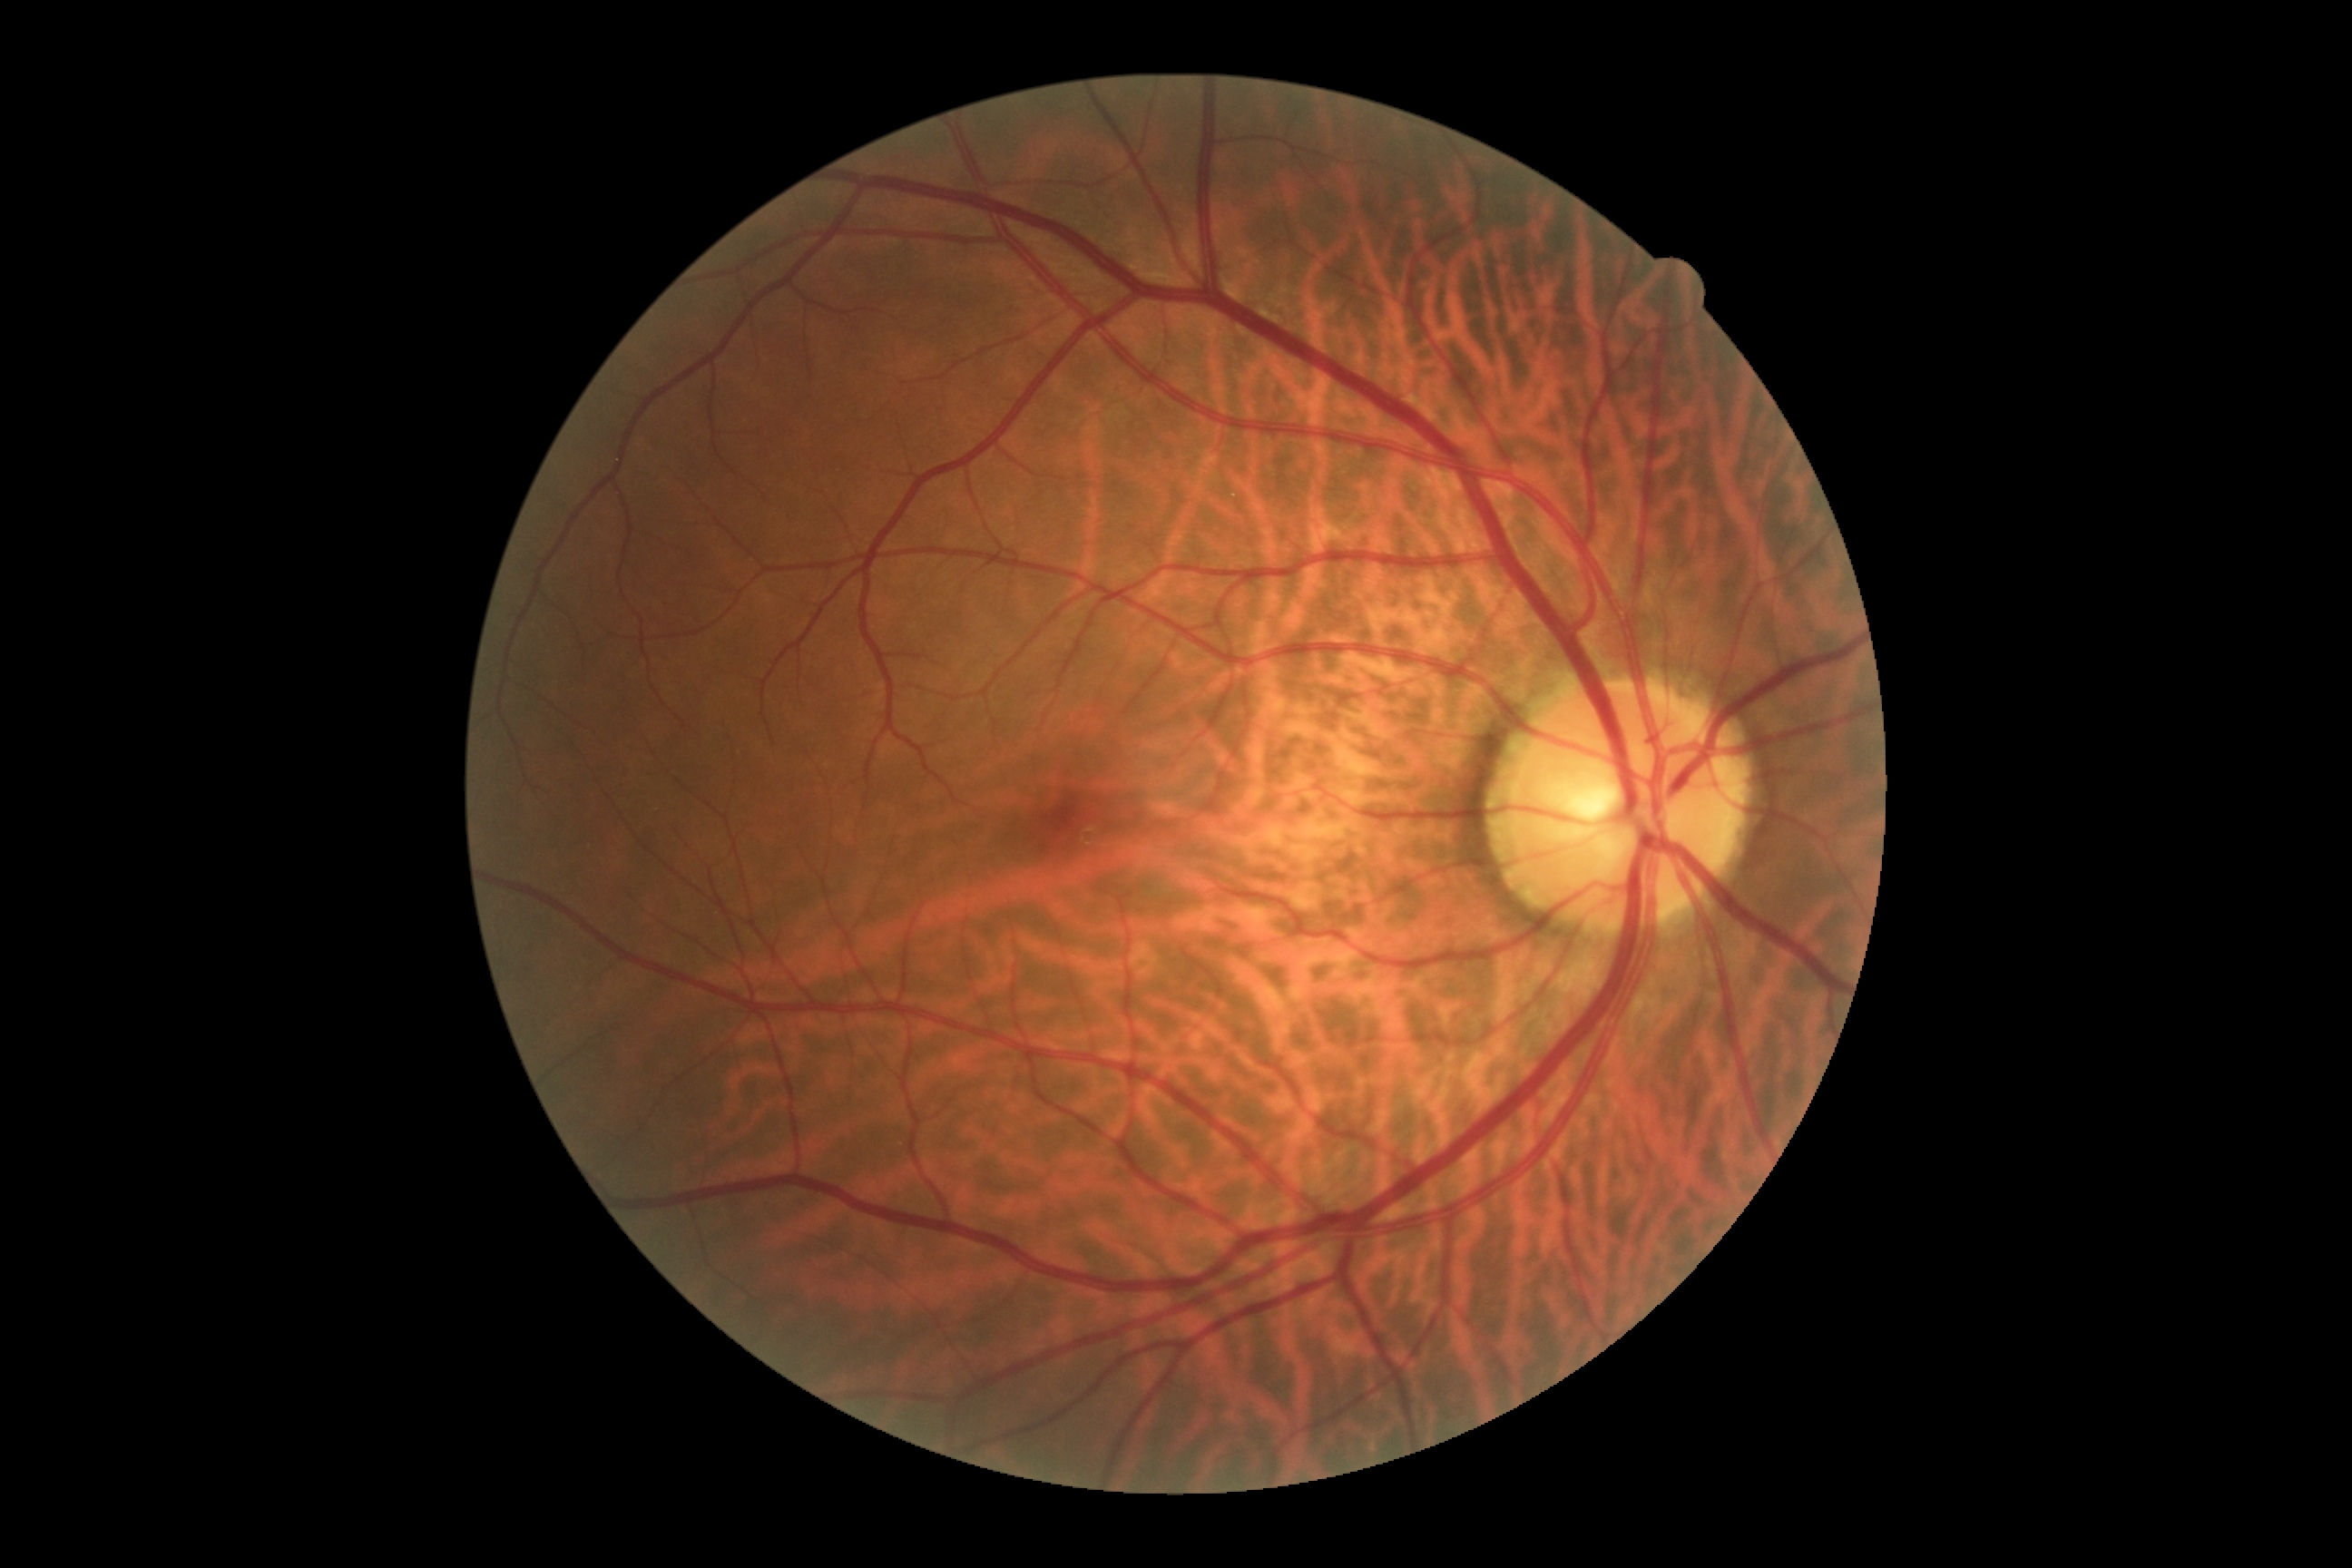
DR severity is grade 0 (no apparent retinopathy).